45° FOV: 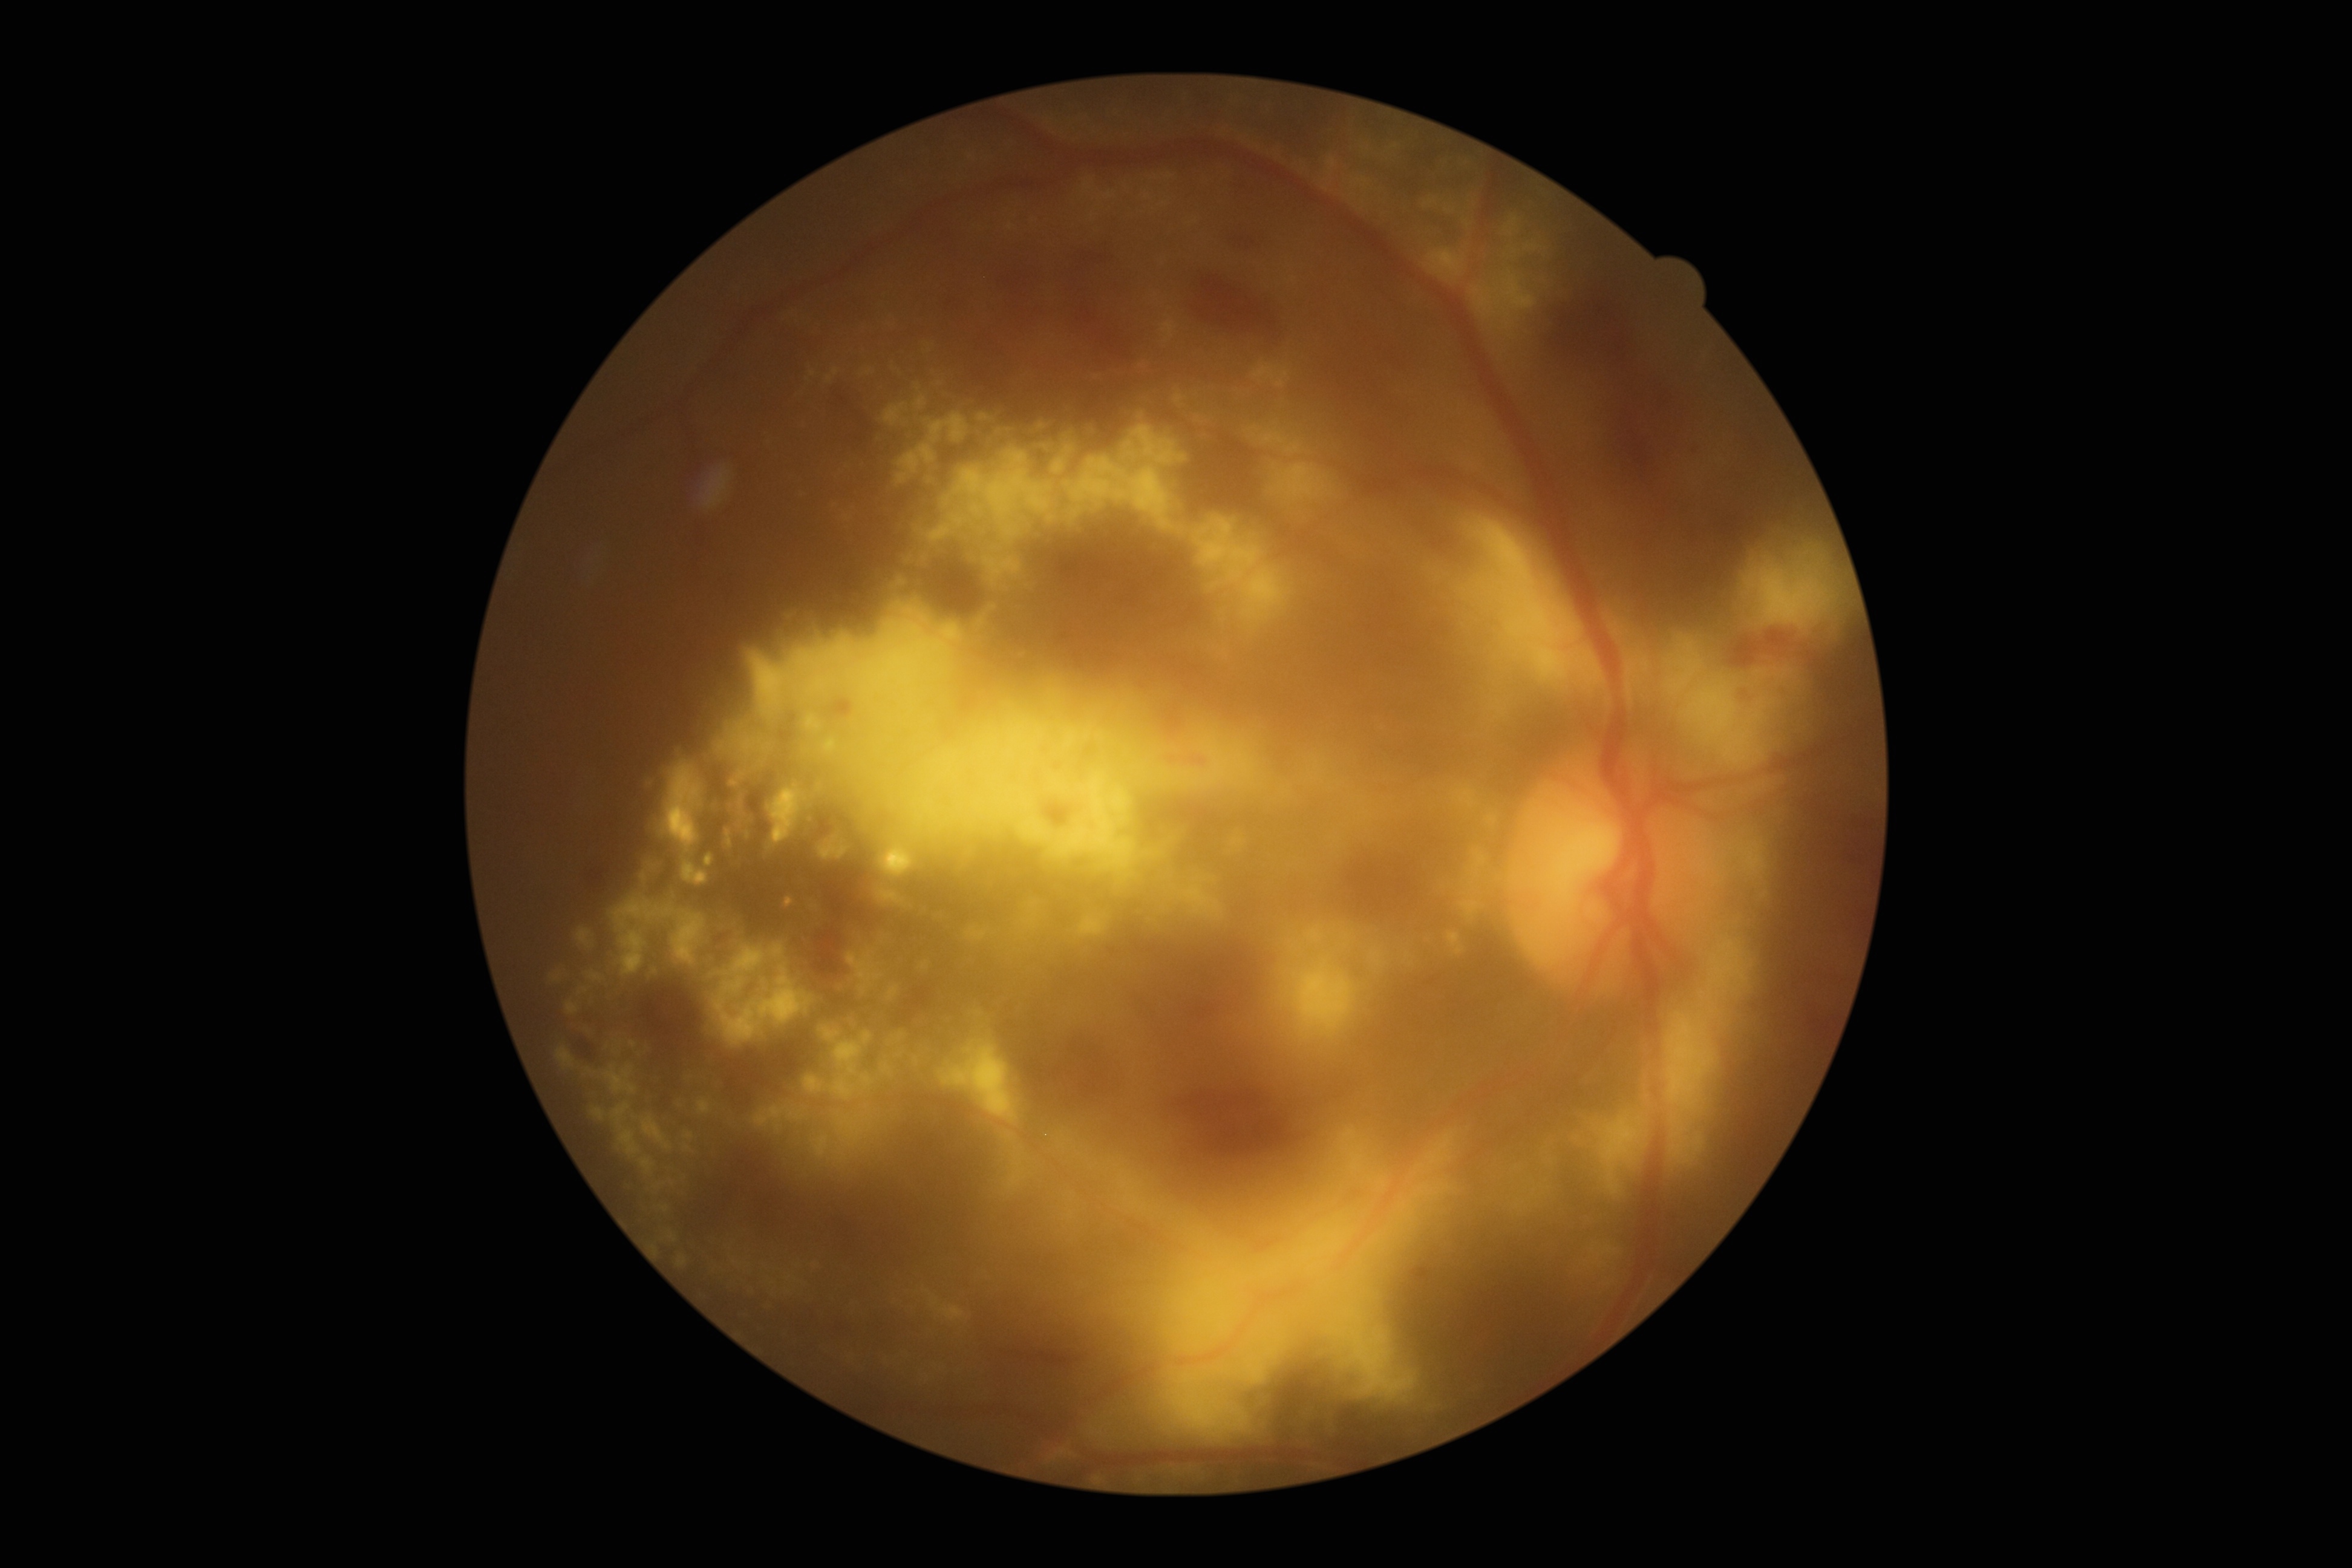
DR: 3/4.
DR class: non-proliferative diabetic retinopathy.